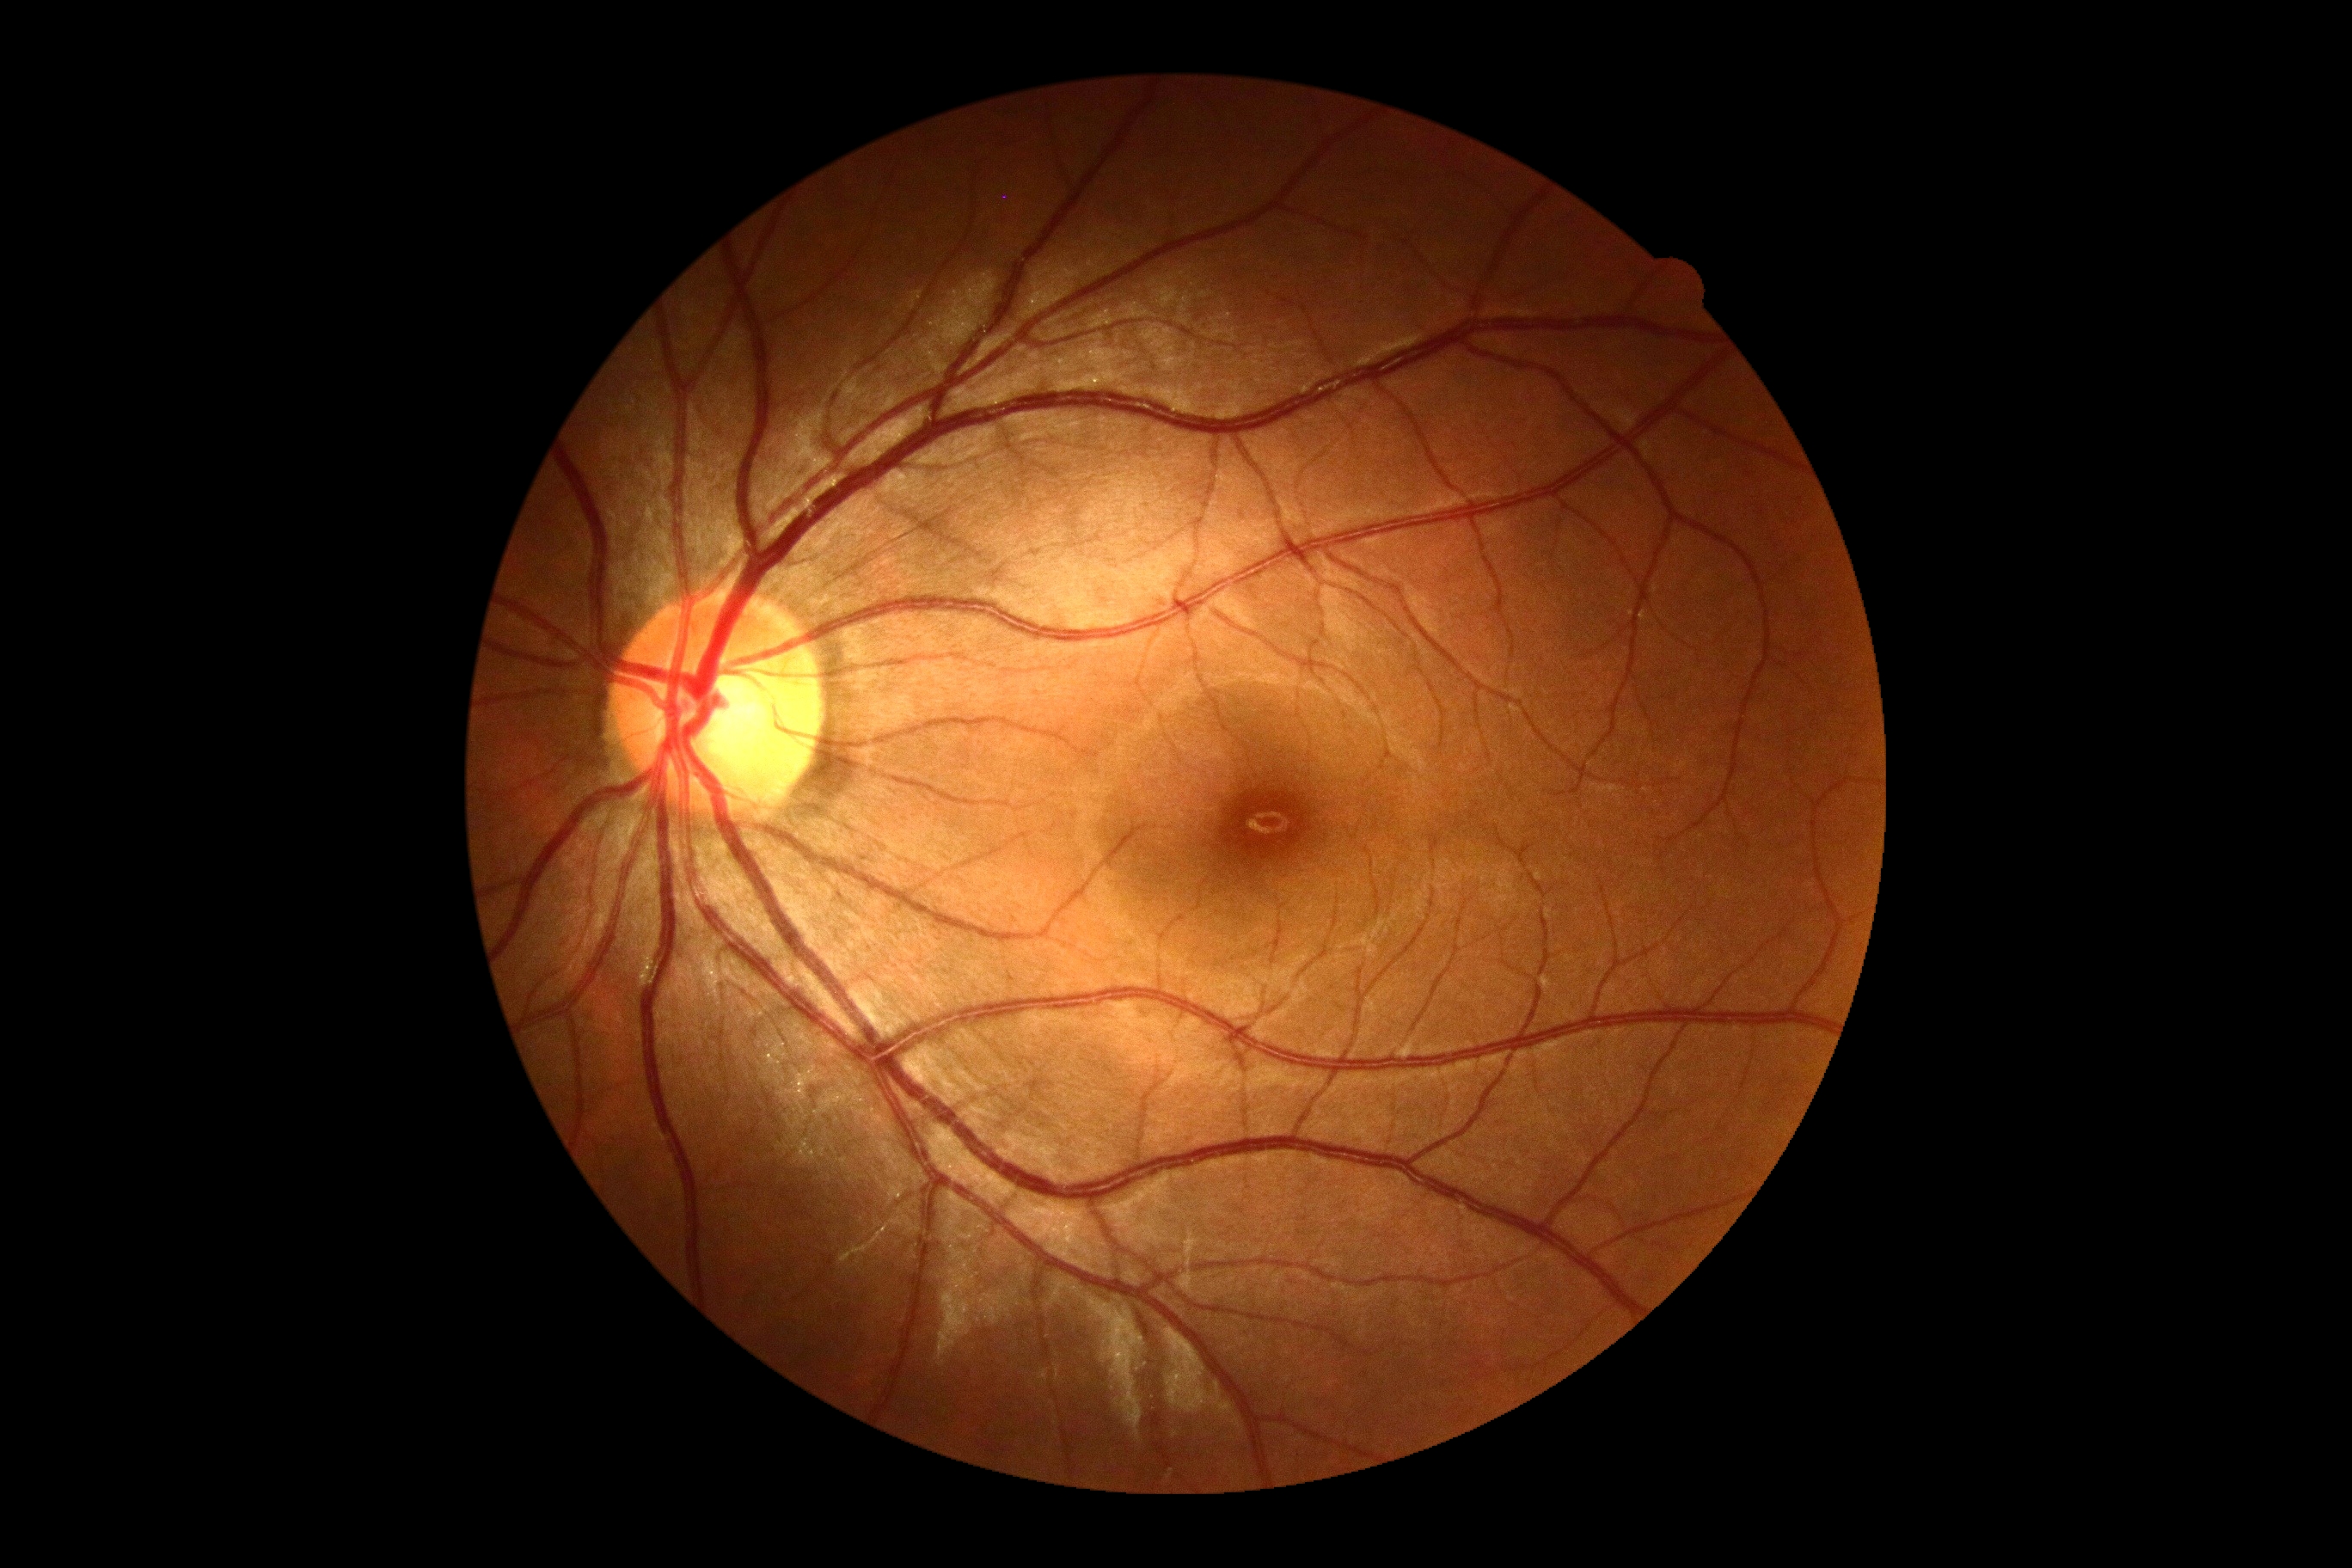

Findings:
• DR stage — no apparent retinopathy (grade 0)